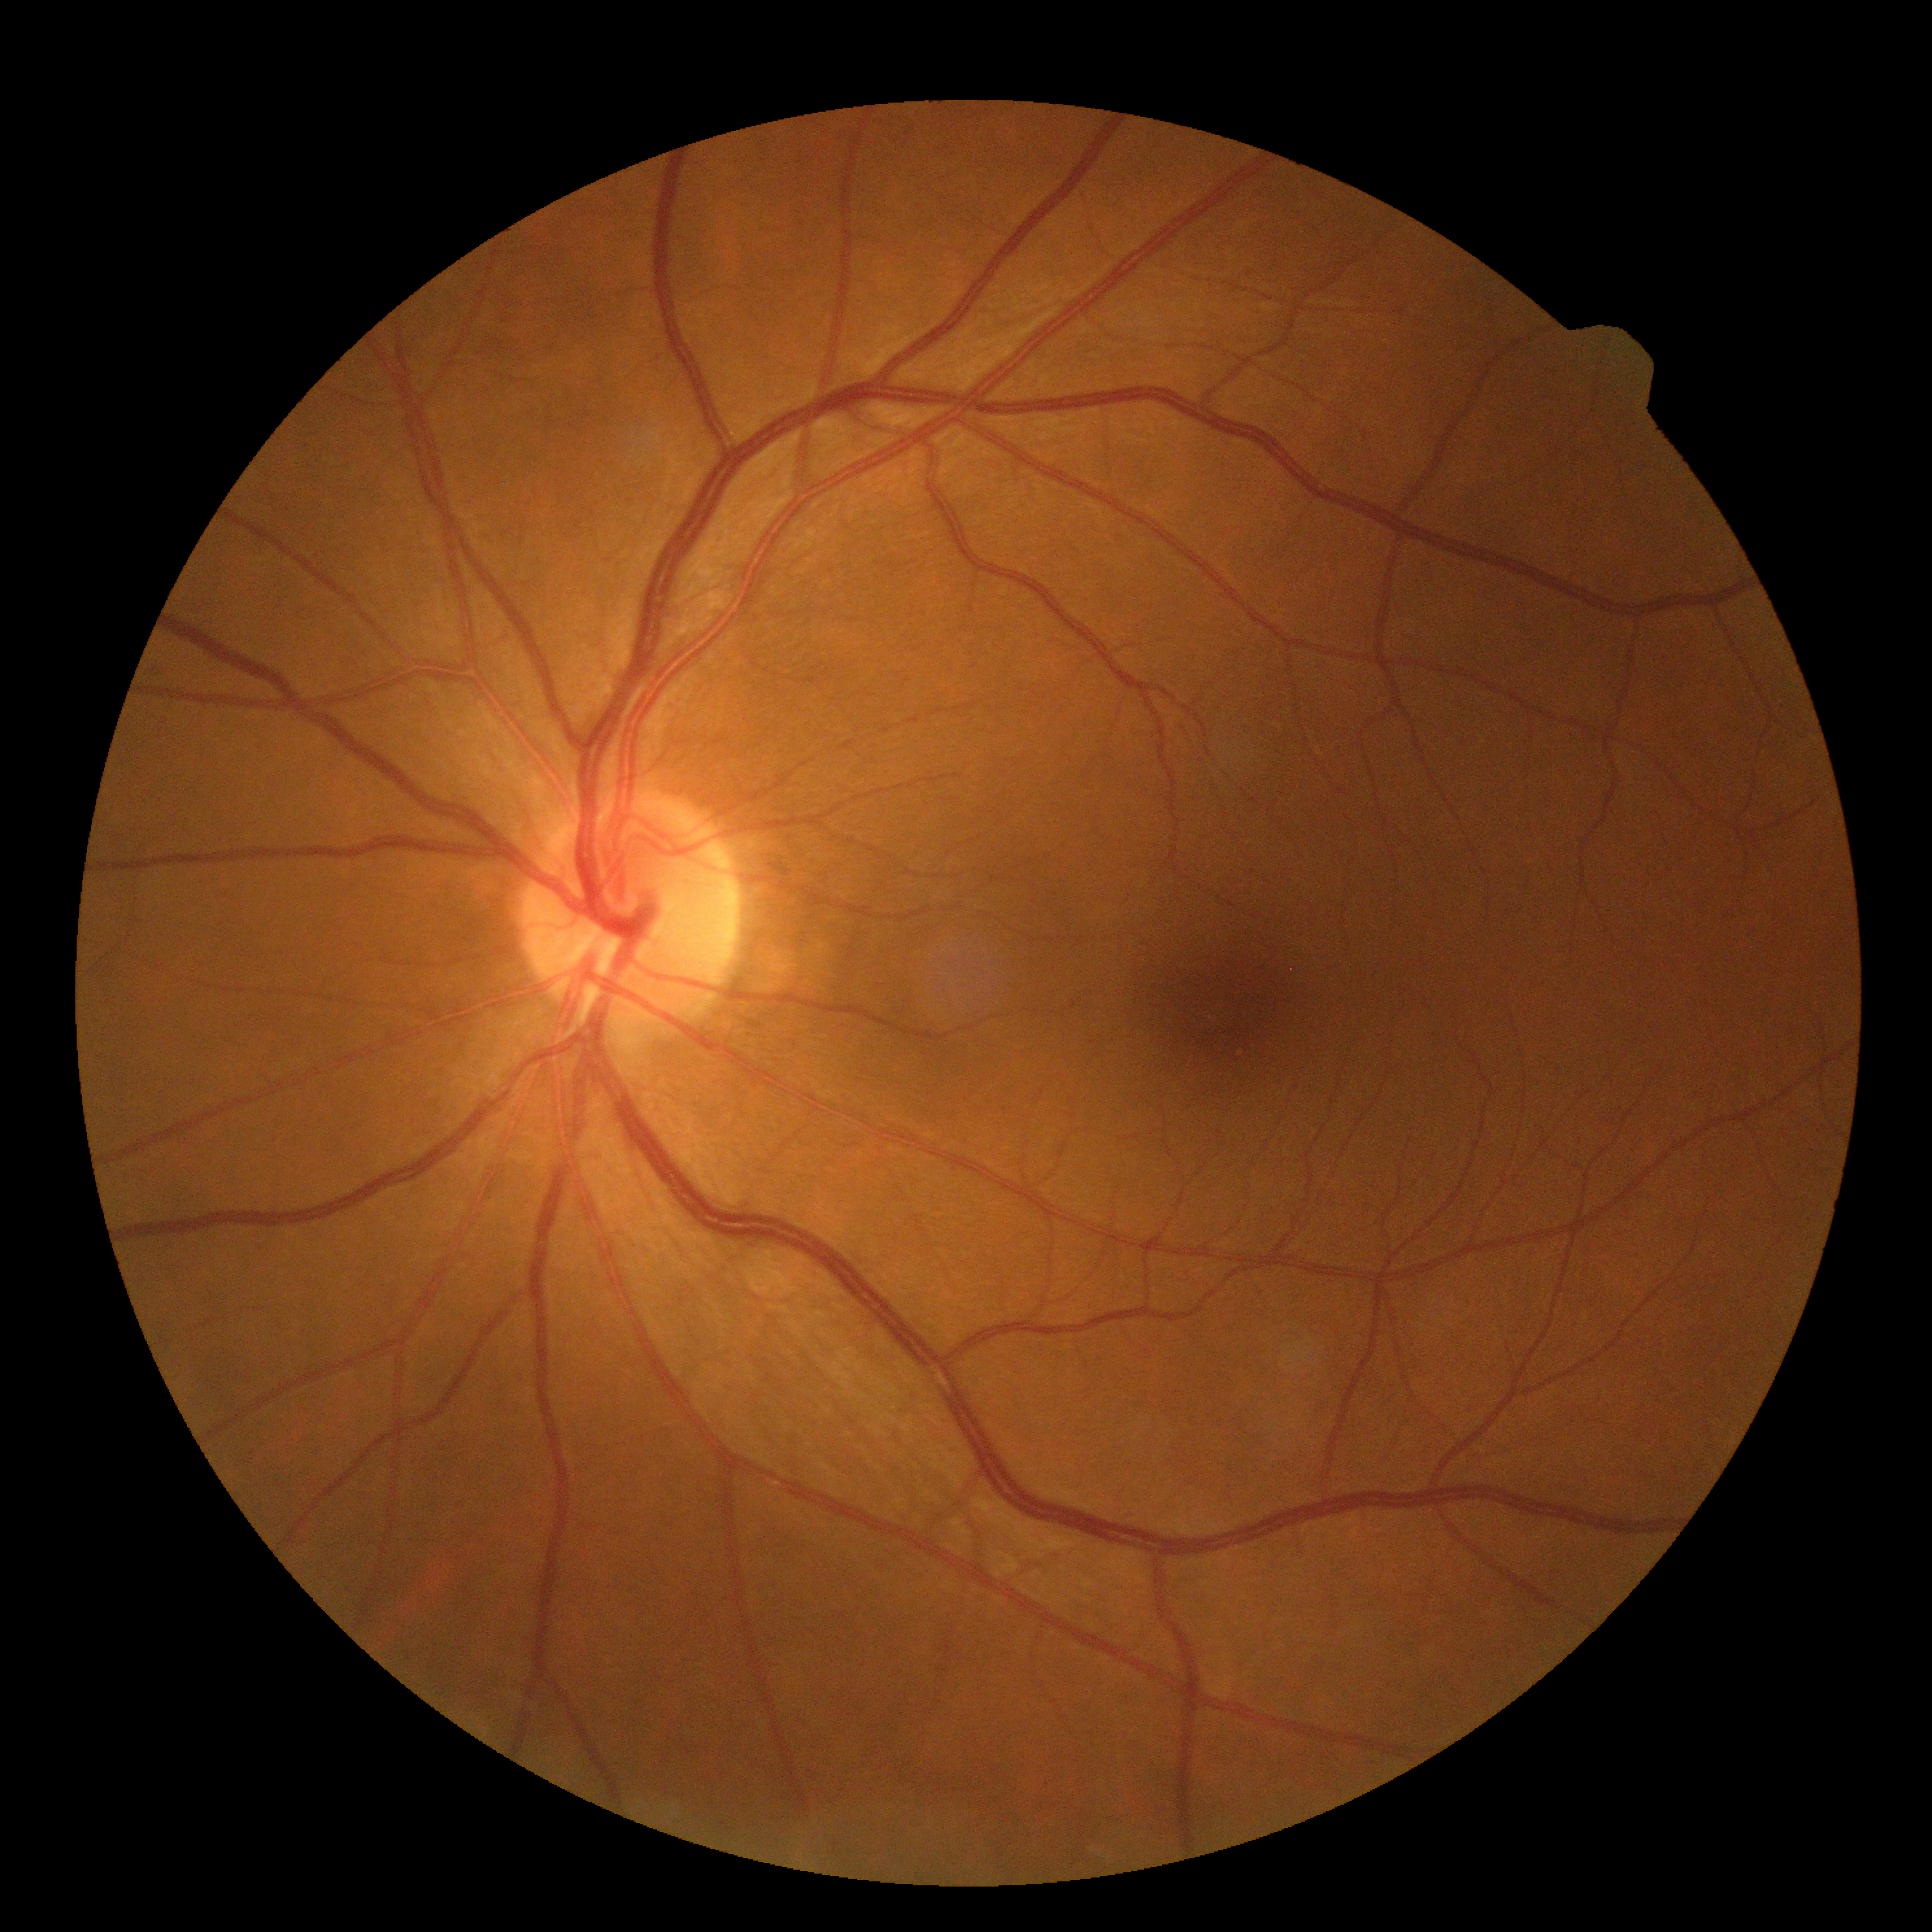

Diabetic retinopathy (DR) is no apparent diabetic retinopathy (grade 0). No apparent diabetic retinopathy.